Color fundus photograph; without pupil dilation; 848x848px; modified Davis classification — 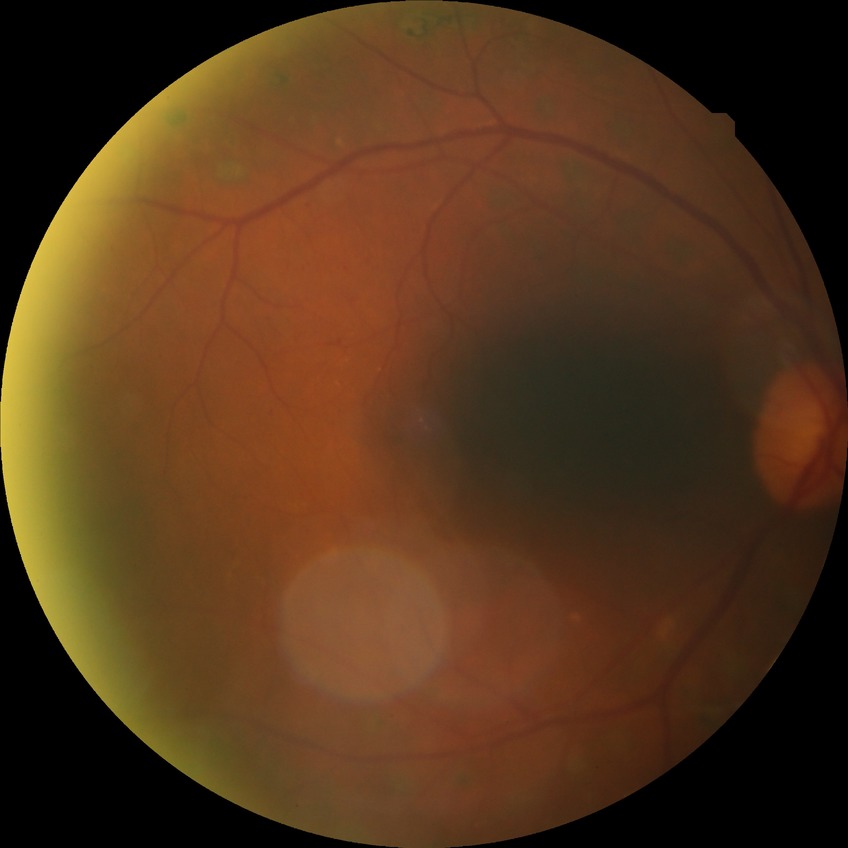 Assessment:
- Davis DR grade — PDR